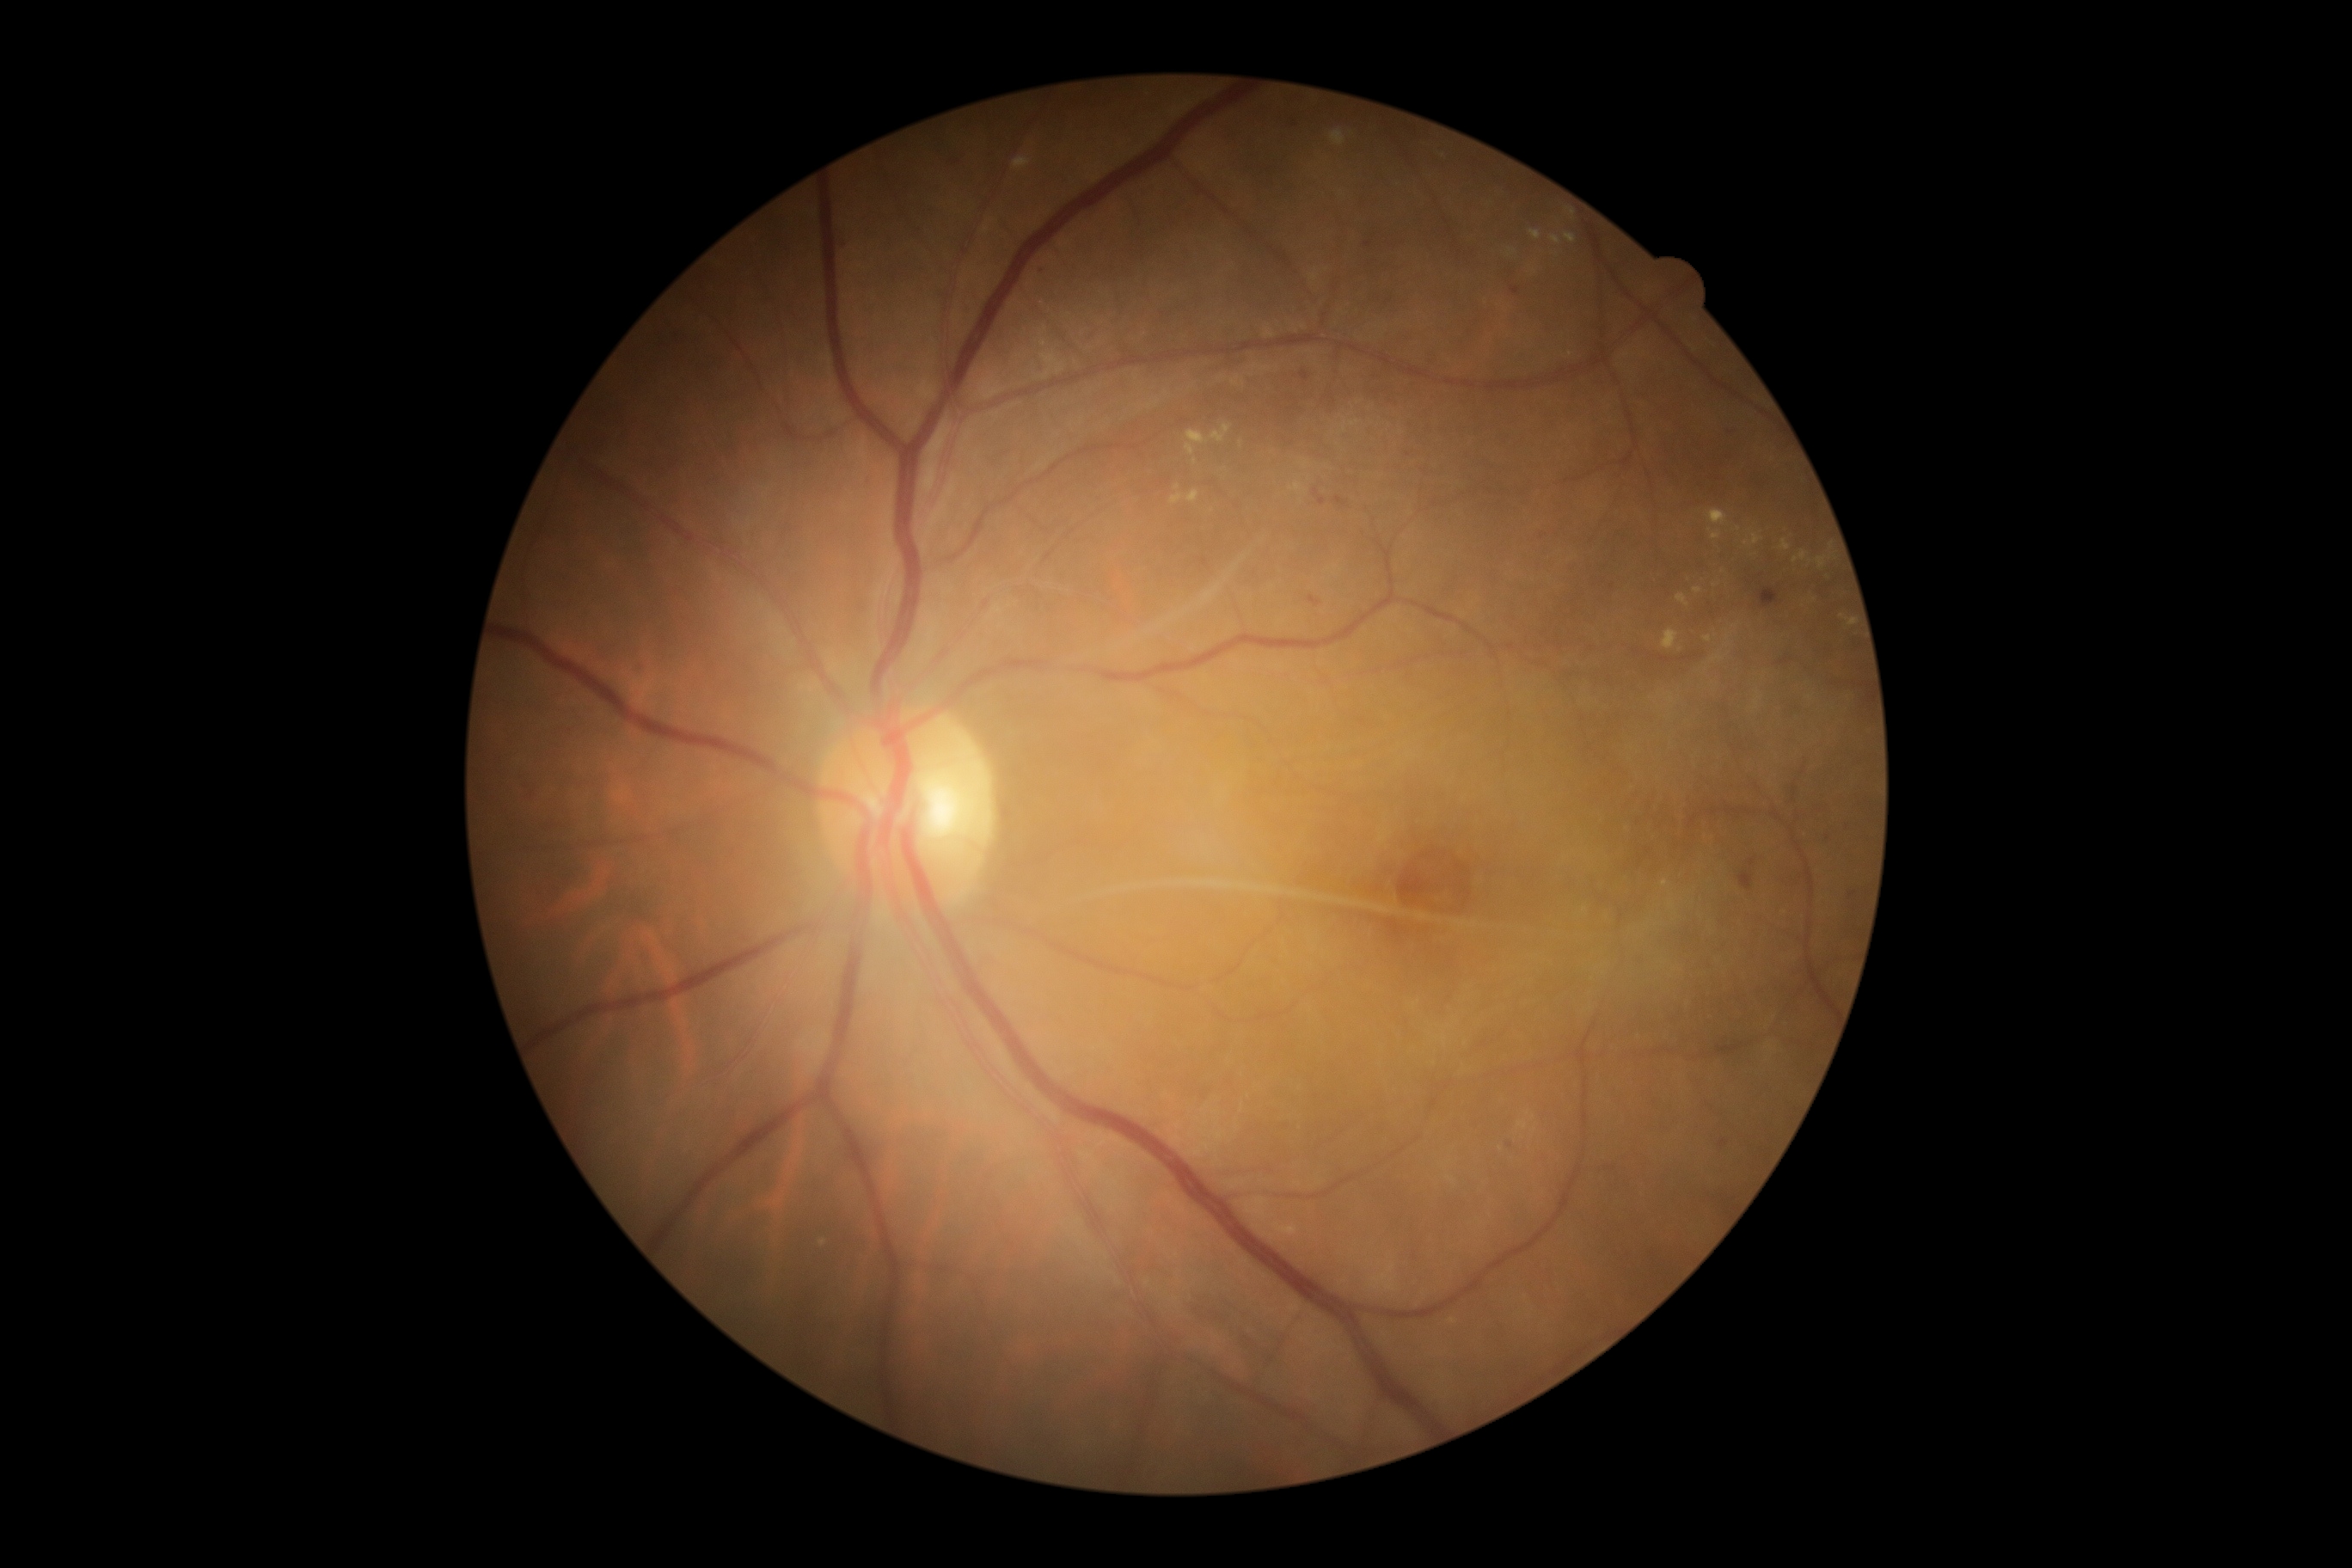
Diabetic retinopathy grade: 2. Hemorrhages include lesions at rect(1746, 573, 1785, 611); rect(1313, 489, 1326, 508); rect(1306, 596, 1323, 608); rect(1737, 857, 1758, 891); rect(1332, 496, 1351, 510). Hard exudates include lesions at rect(1712, 654, 1725, 663); rect(1187, 491, 1199, 503); rect(1708, 510, 1729, 527); rect(1694, 589, 1703, 594); rect(1185, 431, 1208, 456); rect(1708, 529, 1724, 541); rect(1792, 551, 1806, 563); rect(1744, 532, 1763, 546); rect(1271, 1223, 1301, 1237); rect(1565, 233, 1577, 243); rect(1677, 594, 1689, 608); rect(1550, 236, 1562, 245). Additional small hard exudates near Point(1671, 698); Point(1177, 488); Point(1715, 586); Point(1757, 703); Point(1533, 1117); Point(1739, 528); Point(1534, 271); Point(822, 1243). No soft exudates identified. Microaneurysms include lesions at rect(1290, 119, 1299, 128); rect(1301, 371, 1309, 386); rect(642, 668, 647, 677); rect(1849, 891, 1858, 900); rect(1510, 286, 1521, 297); rect(1363, 233, 1378, 250); rect(1718, 1139, 1730, 1149); rect(1727, 431, 1736, 436); rect(1540, 532, 1547, 541). Additional small microaneurysms near Point(1848, 827); Point(1828, 839); Point(1510, 1146); Point(1042, 271).